Infant wide-field fundus photograph:
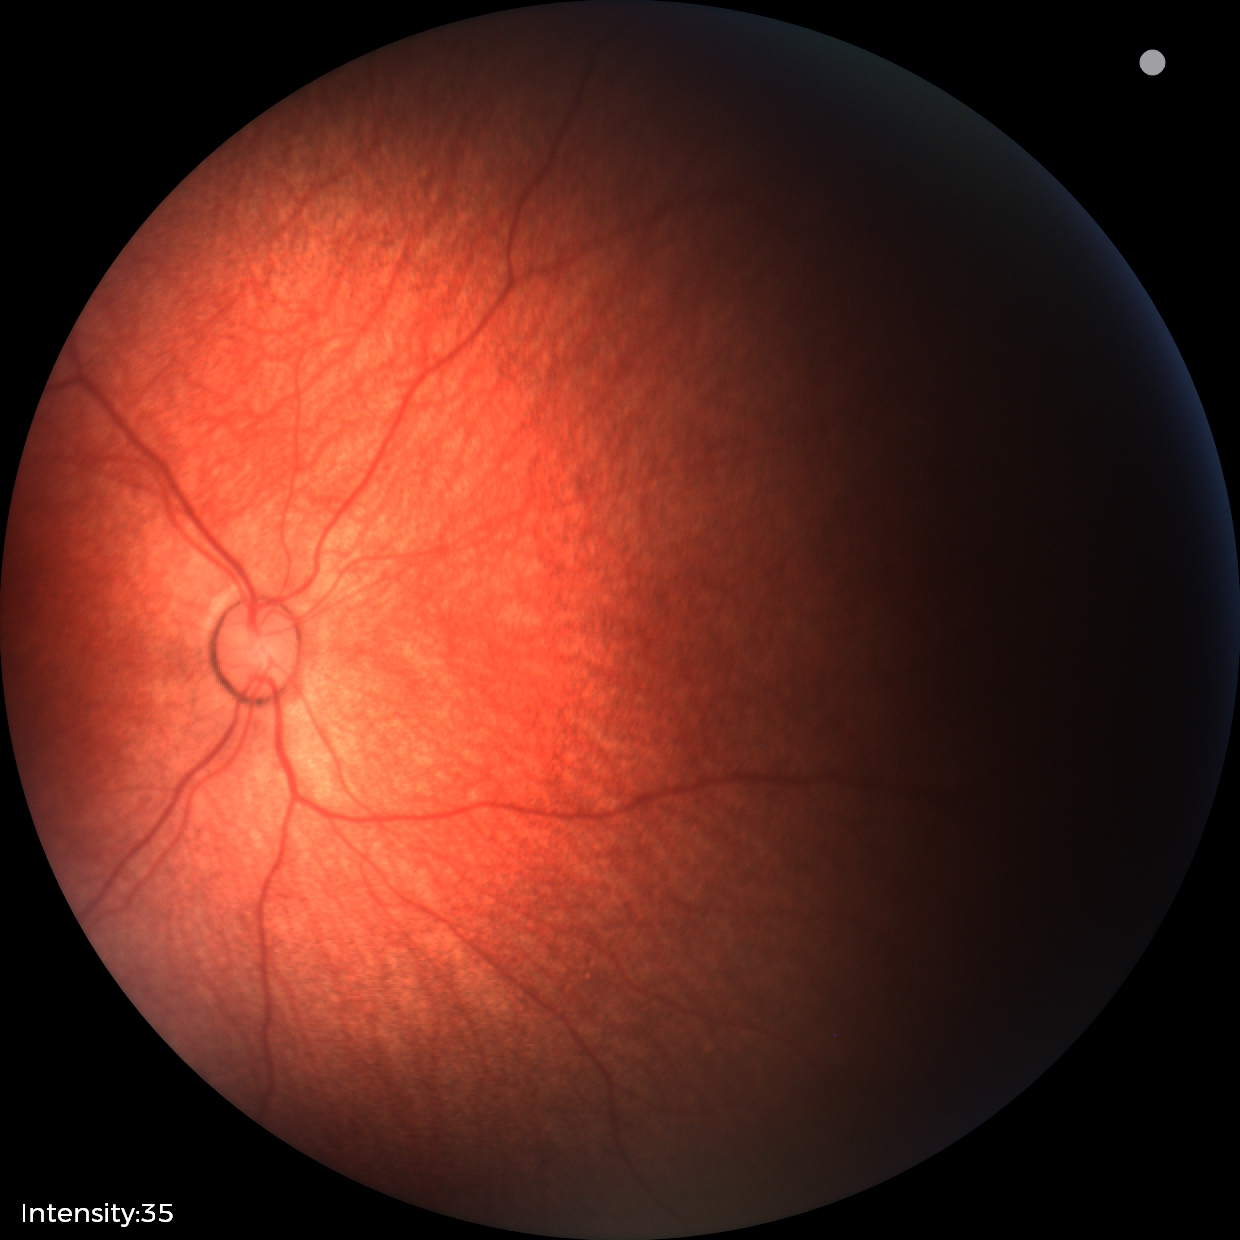 Diagnosis = physiological.